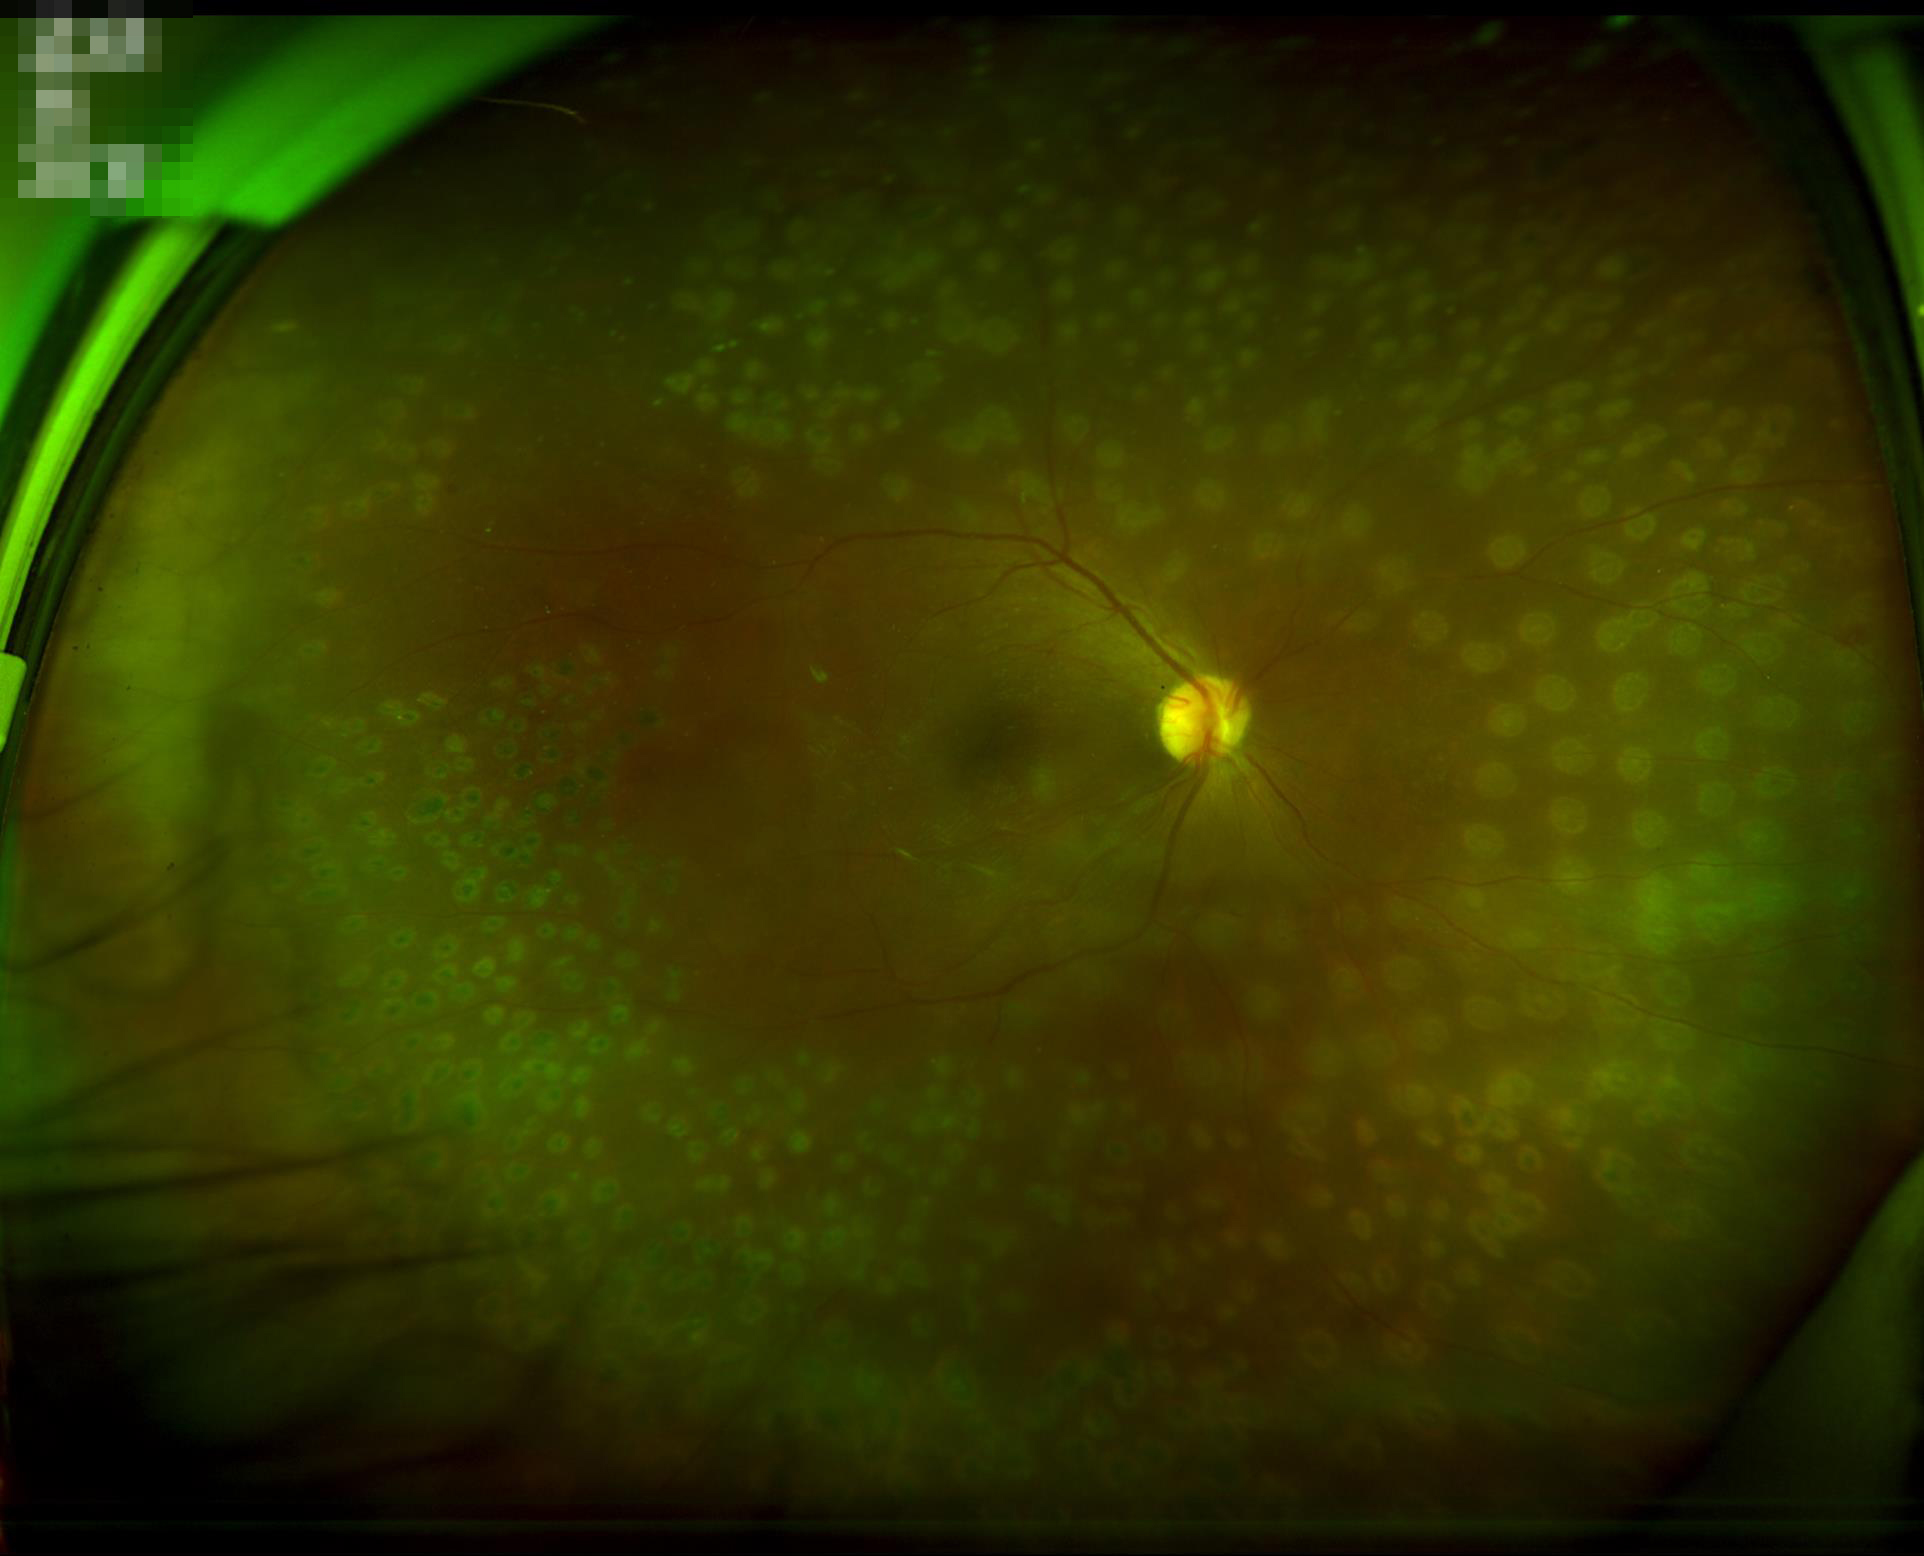 overall_quality: good
illumination: good
clarity: clear
contrast: good